Modified Davis classification; 848 x 848 pixels; NIDEK AFC-230 fundus camera; FOV: 45 degrees — 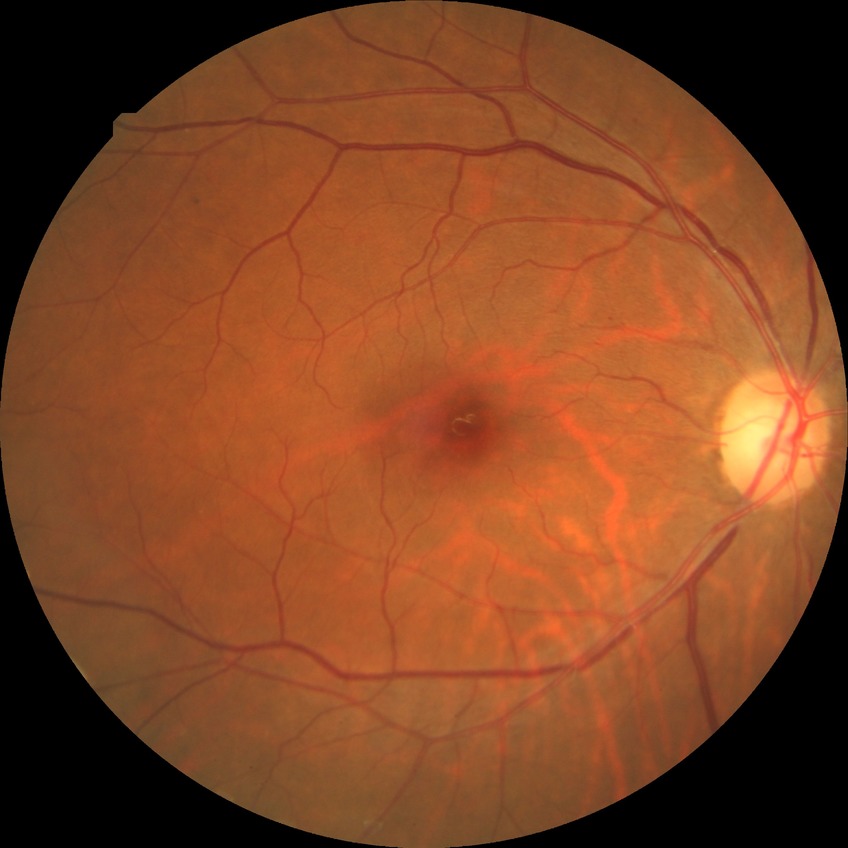

Diabetic retinopathy (DR): simple diabetic retinopathy (SDR). The retinopathy is classified as non-proliferative diabetic retinopathy.